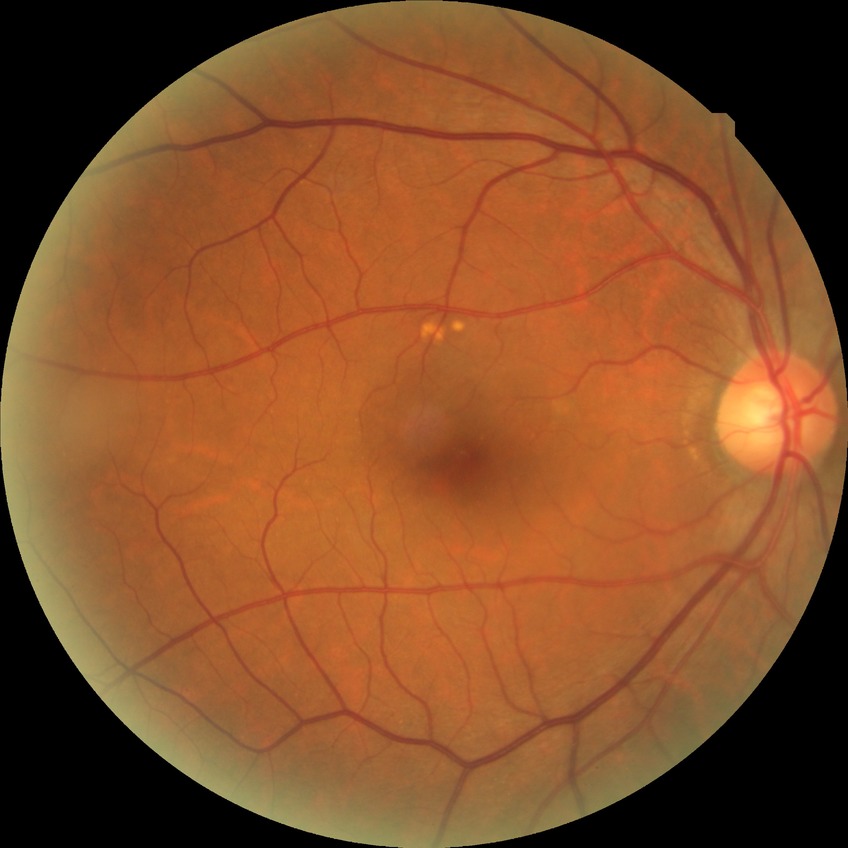 diabetic retinopathy grade=simple diabetic retinopathy.